DR severity per modified Davis staging.
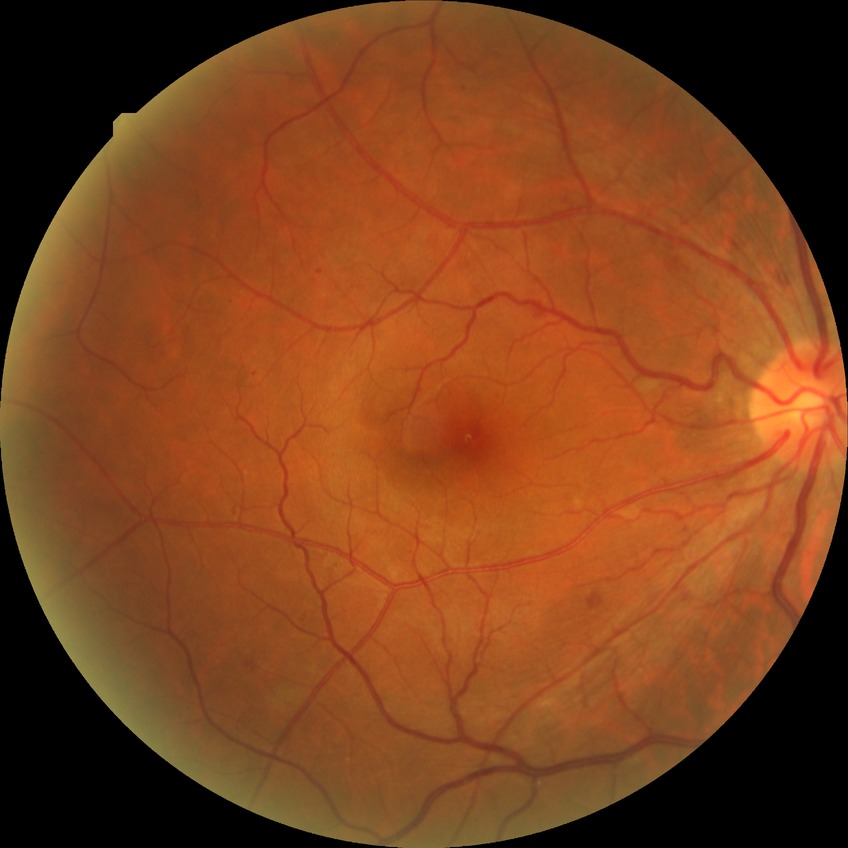 {"davis_grade": "simple diabetic retinopathy"}